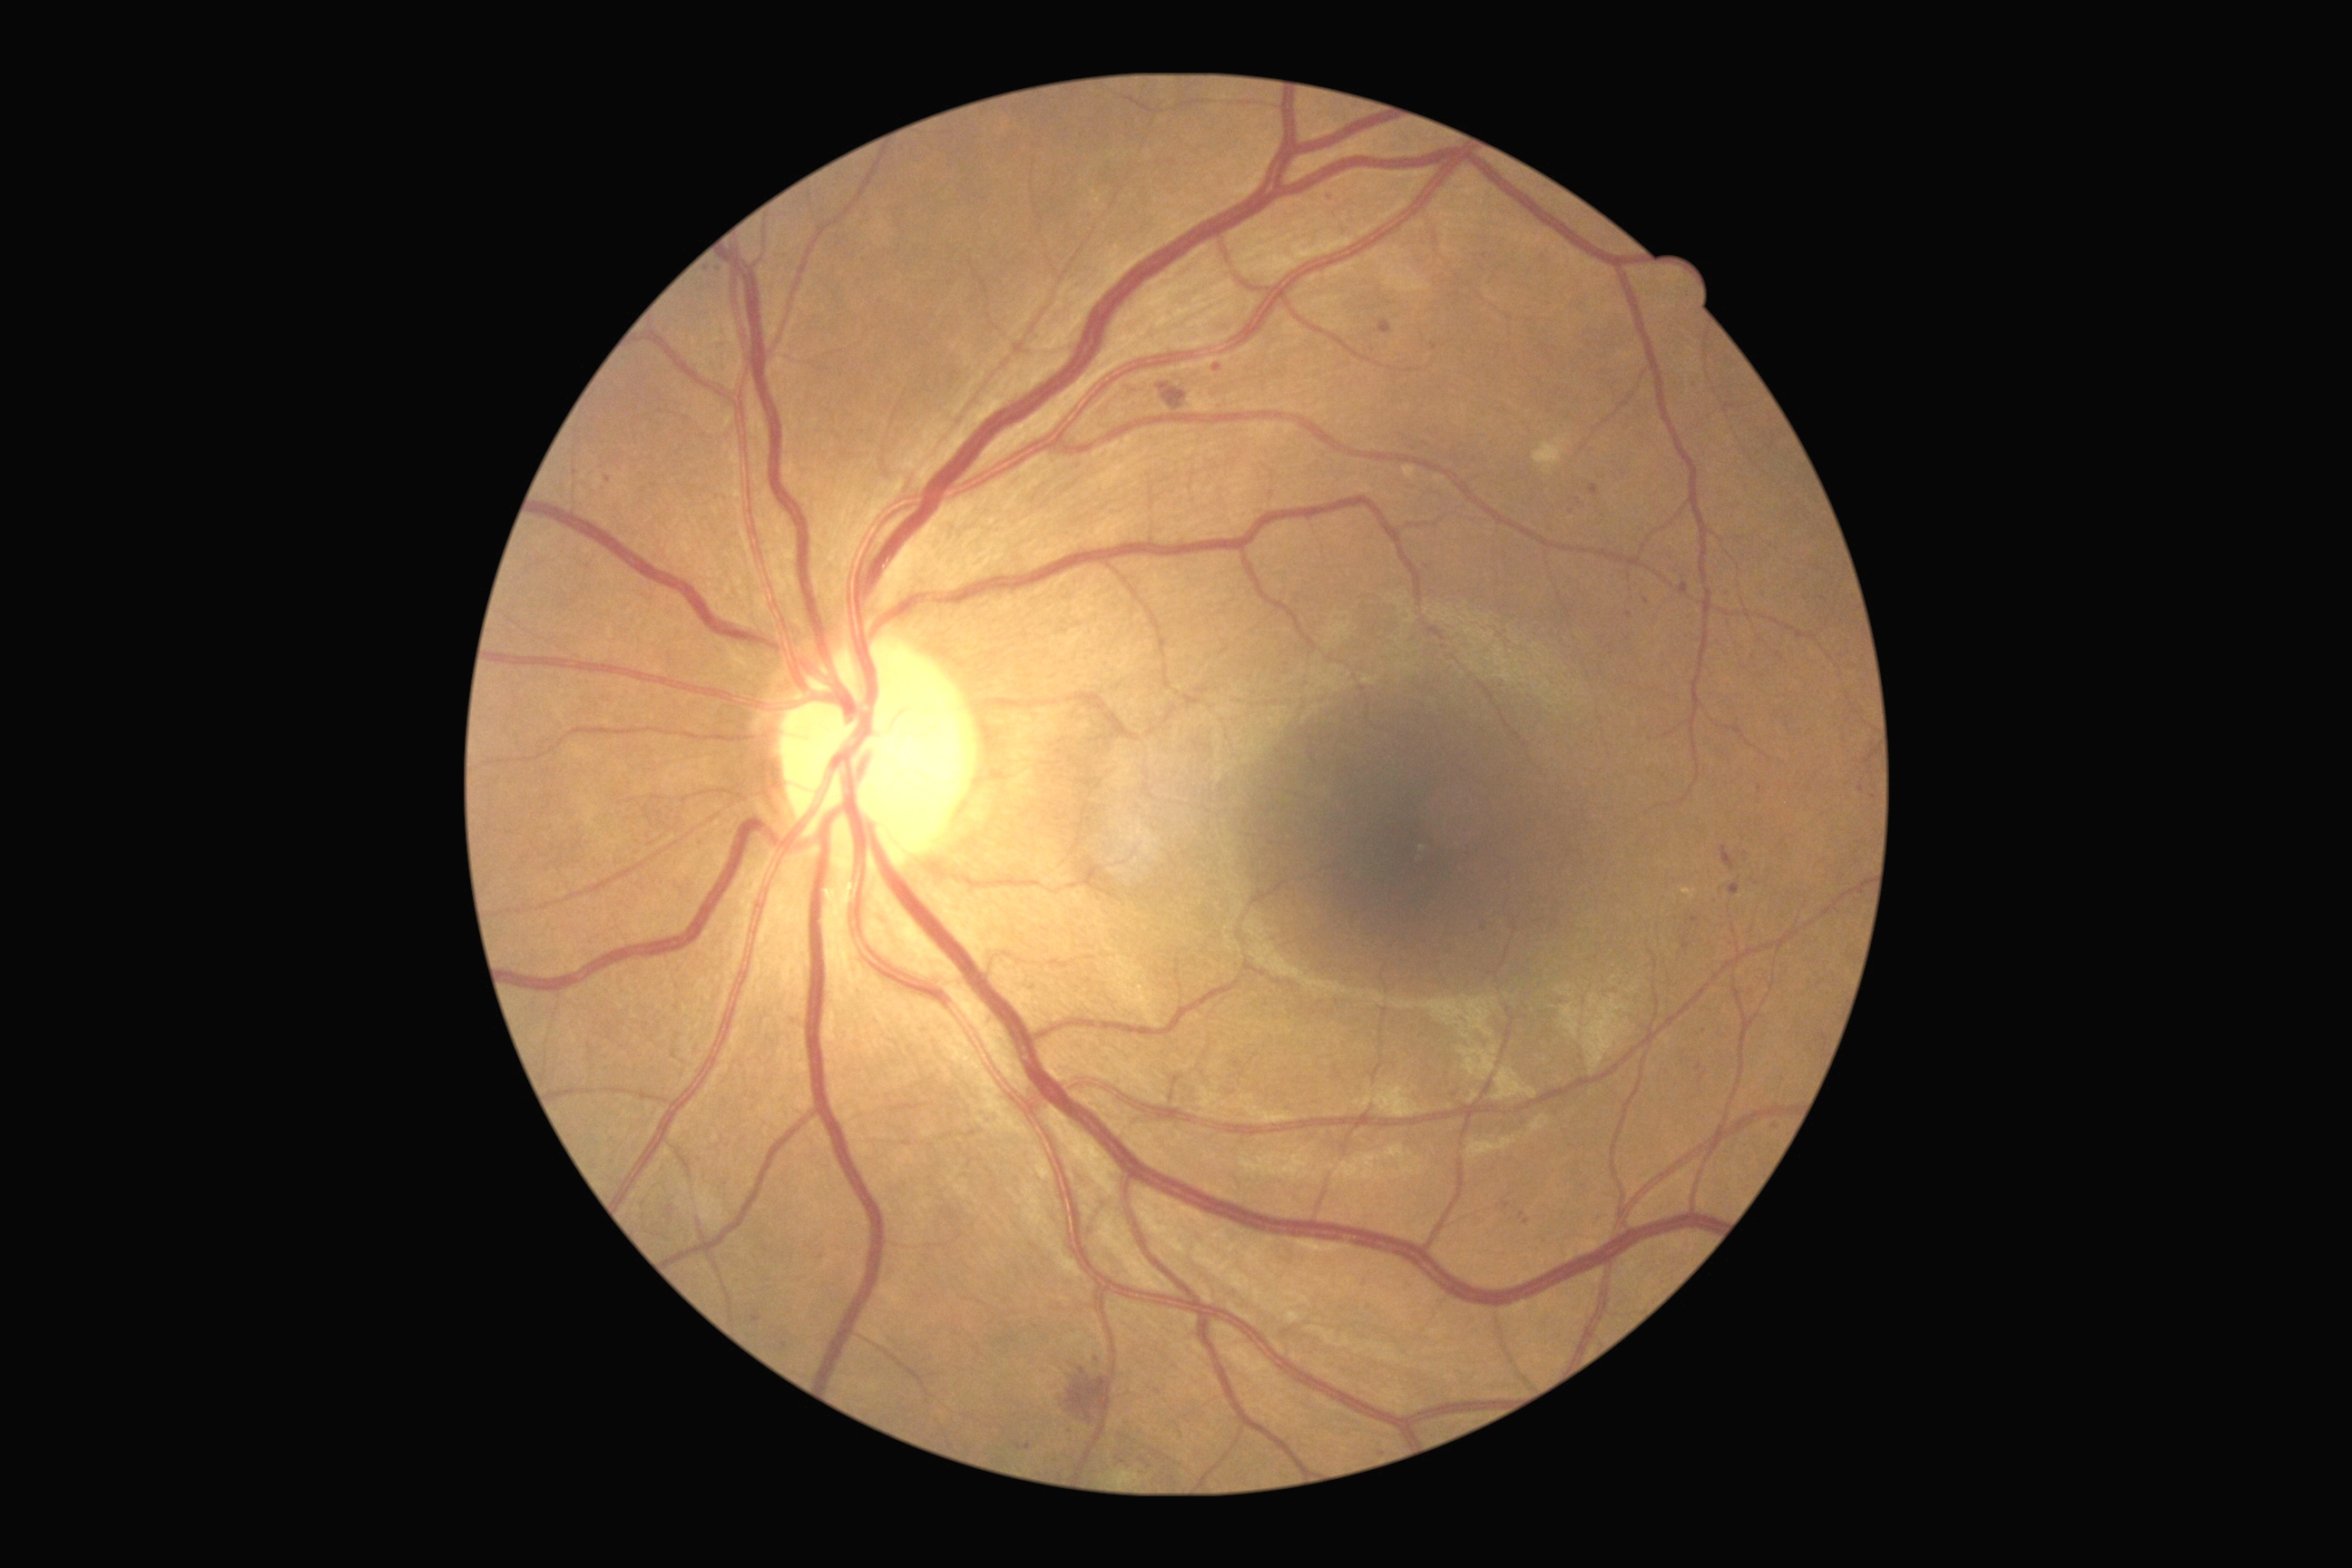
diabetic retinopathy (DR): 2/4.